2212 by 1659 pixels
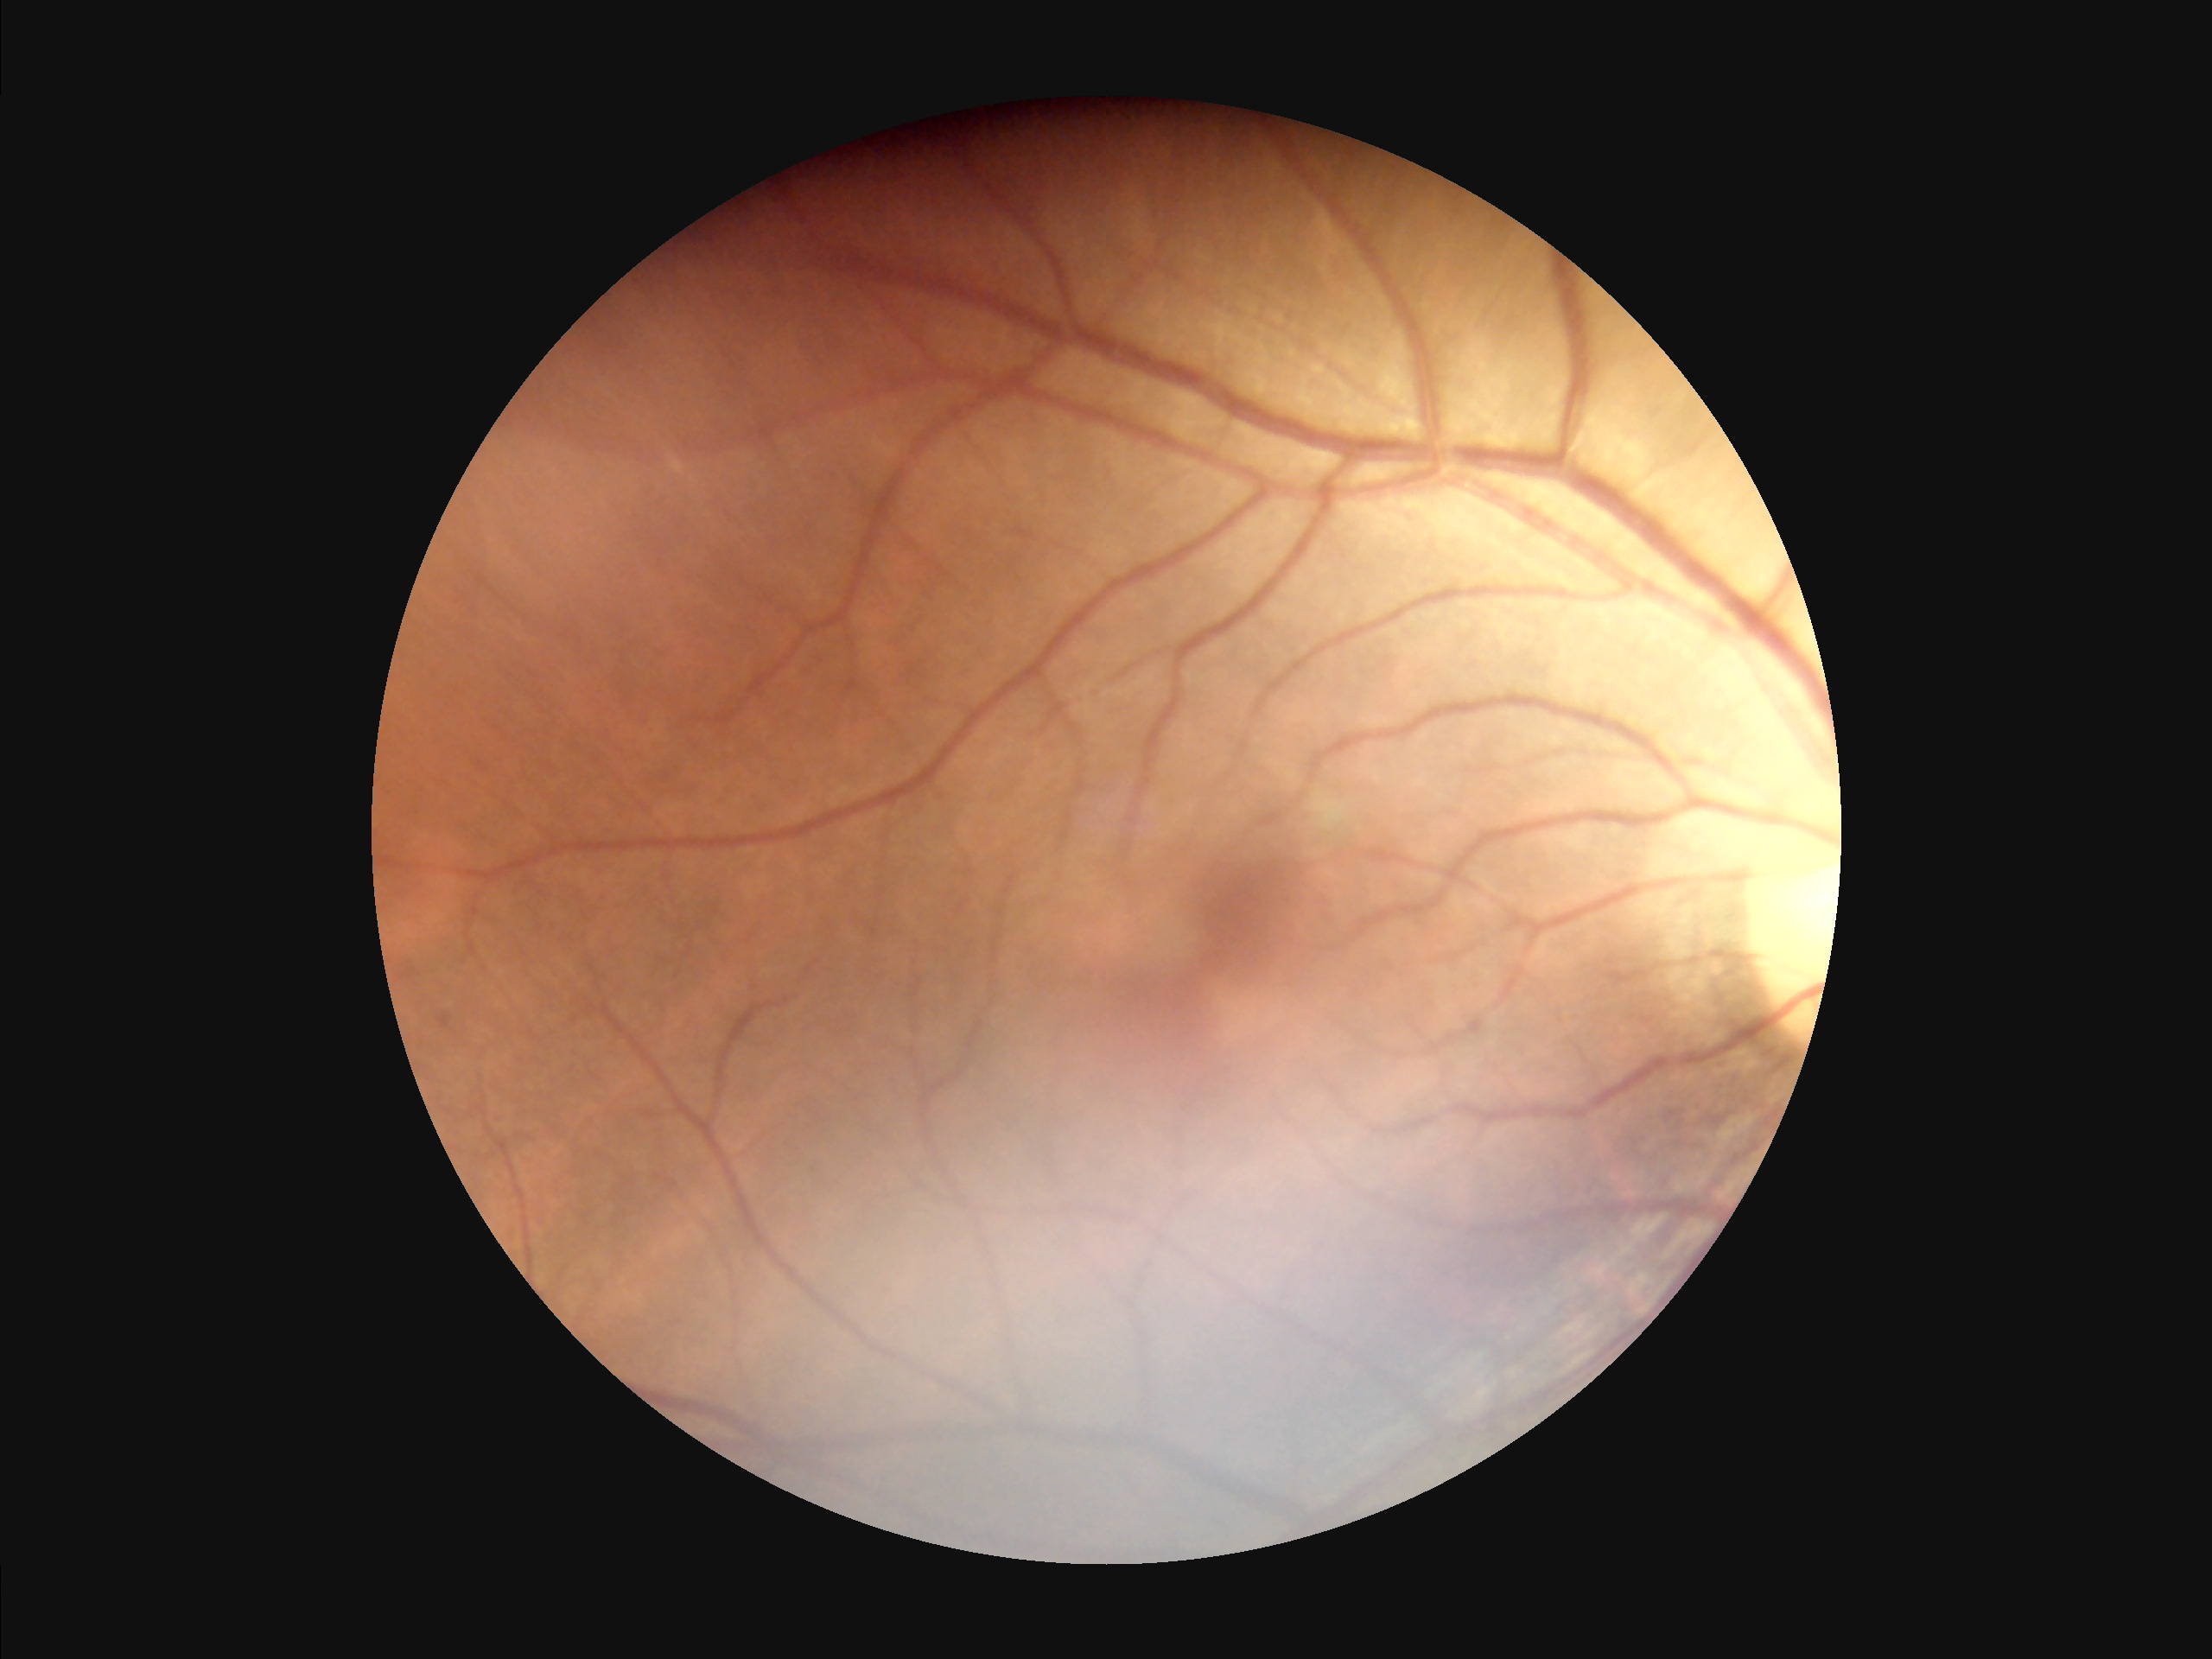 Acceptable image quality.
The image is blurry.
No over- or under-exposure.
Good dynamic range.